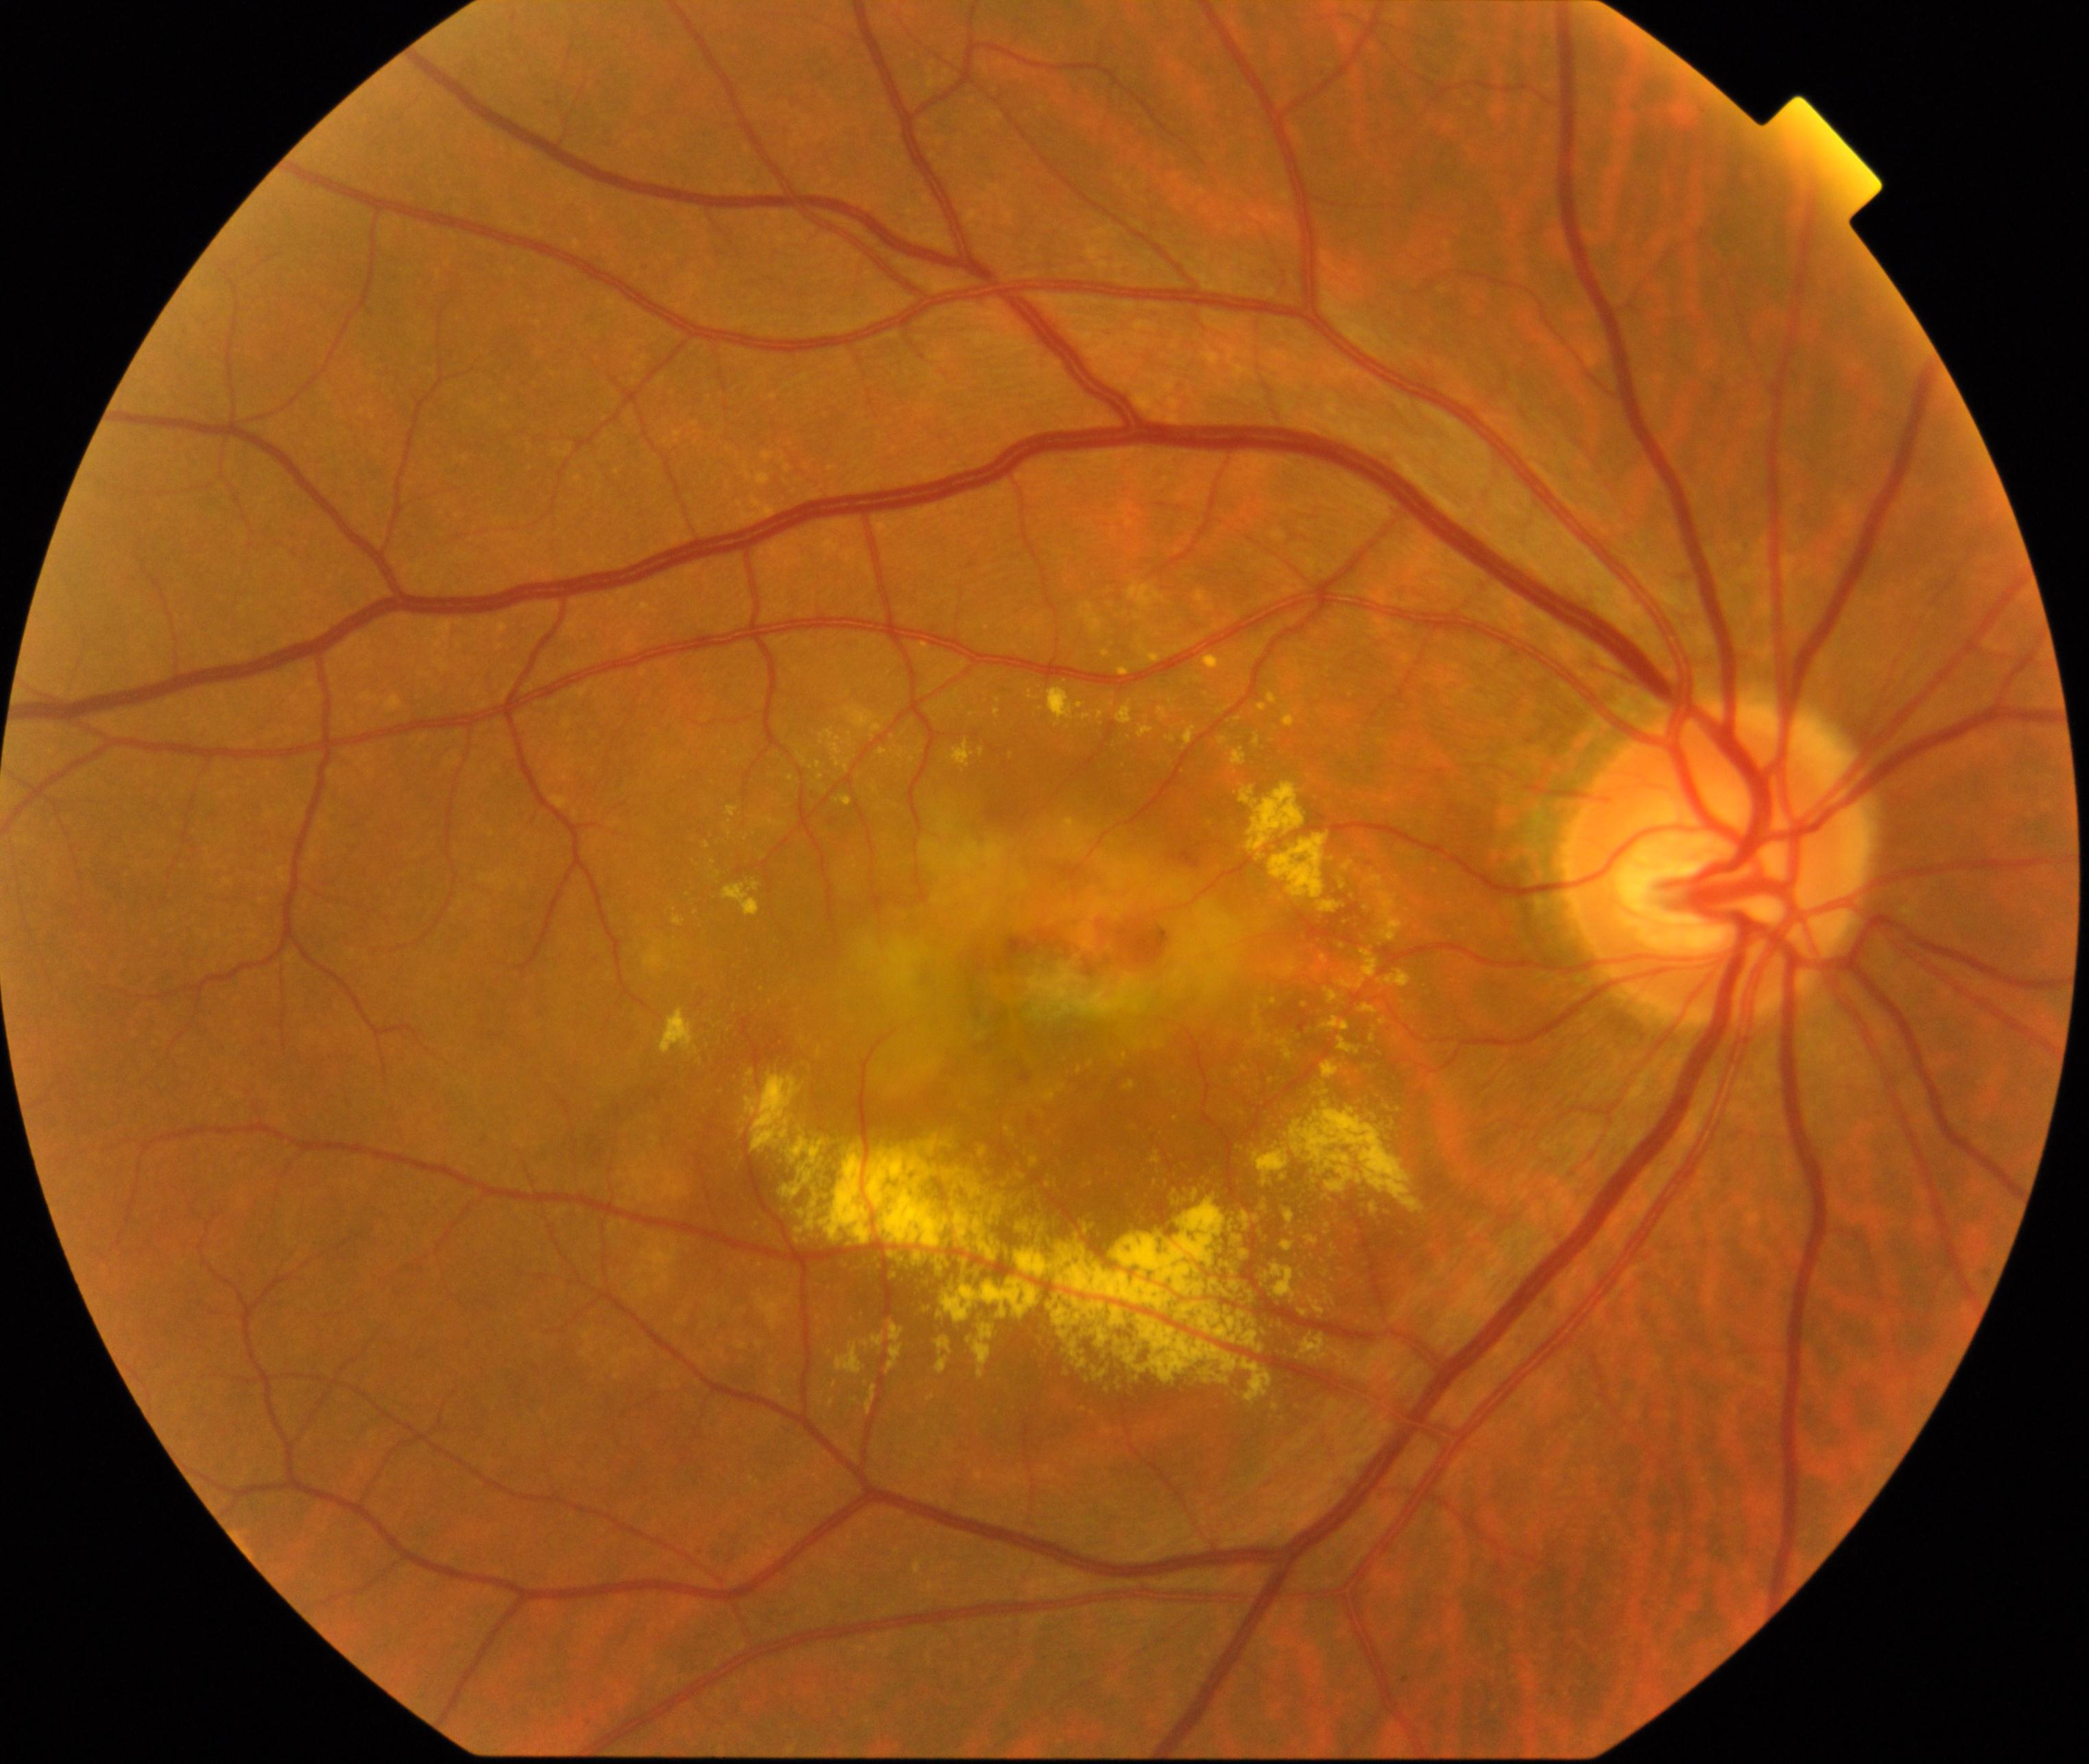

Demonstrates maculopathy.